Camera: Phoenix ICON (100° FOV) · wide-field contact fundus photograph of an infant: 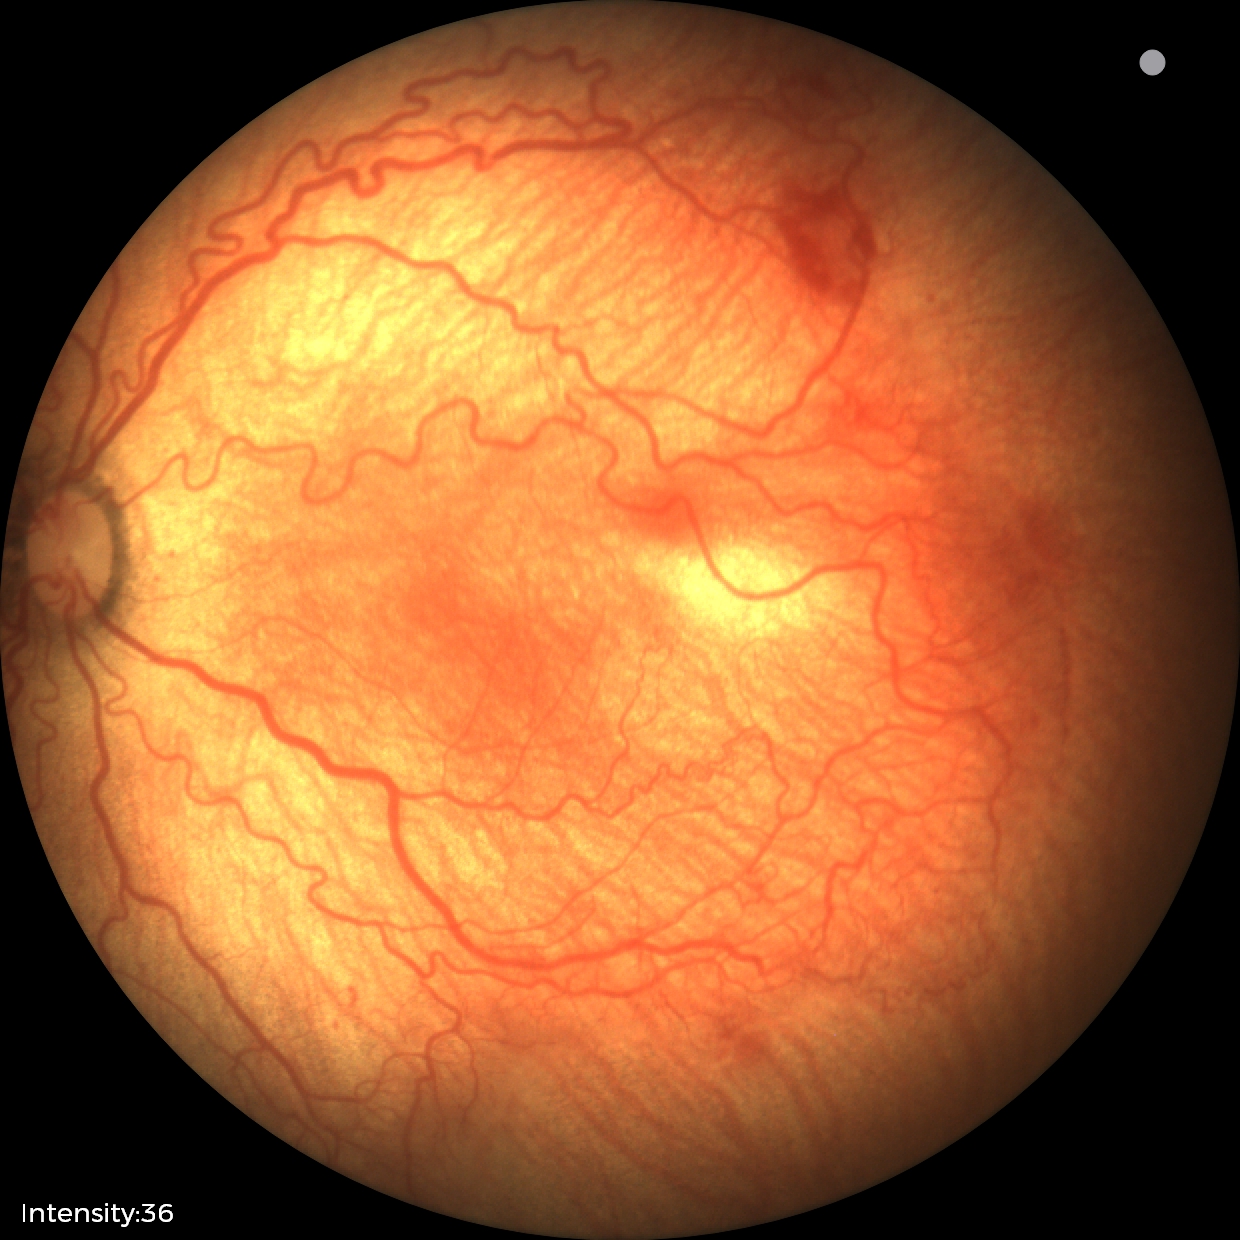 Impression: ROP stage 2; plus disease.